130° field of view (Clarity RetCam 3) · wide-field fundus image from infant ROP screening: 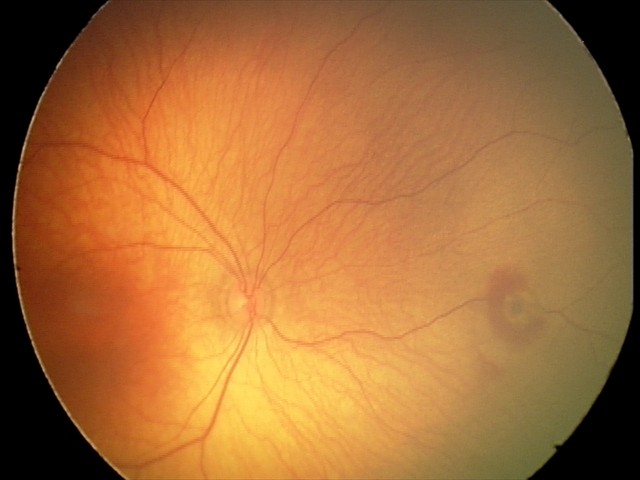 Q: What is the diagnosis from this examination?
A: retinal hemorrhages